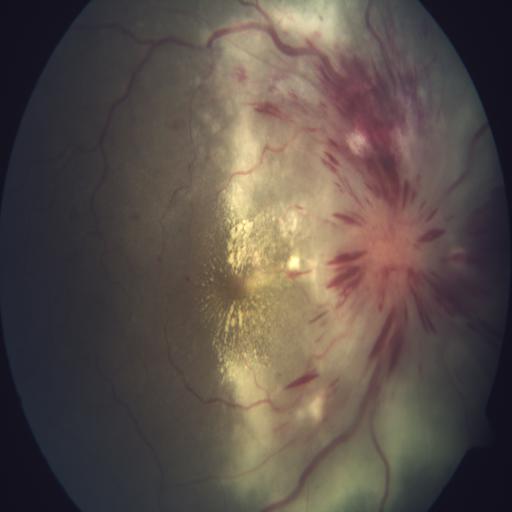

There is evidence of optic neuritis and exudation.